Acquired with a NIDEK AFC-230, nonmydriatic fundus photograph
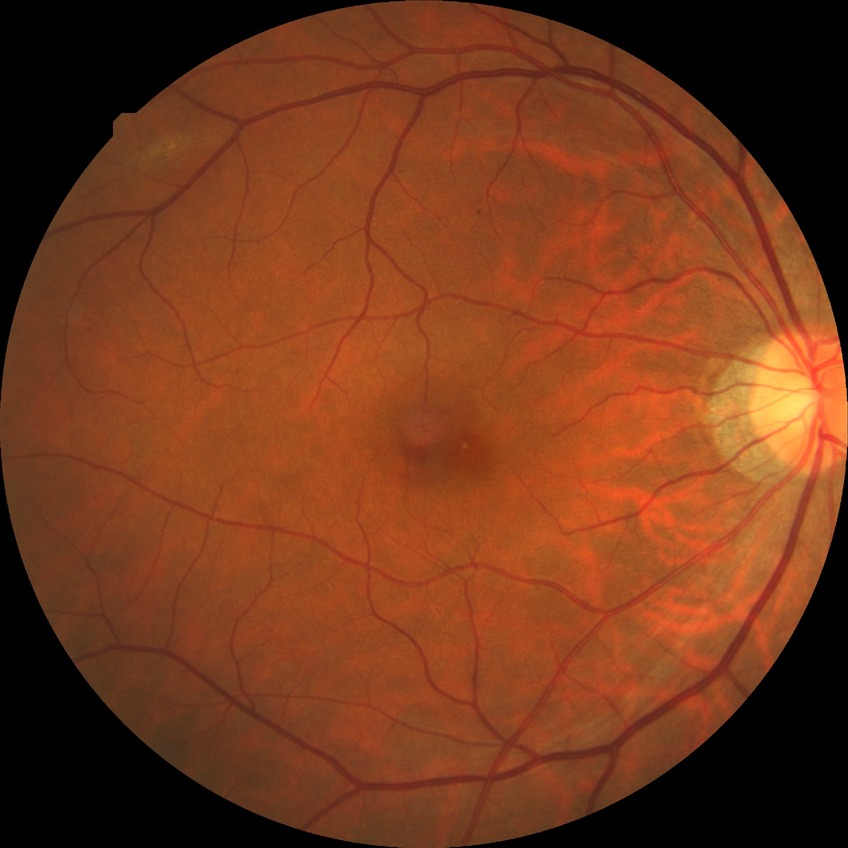
Diabetic retinopathy (DR): SDR (simple diabetic retinopathy).